Color fundus photograph from a handheld portable camera.
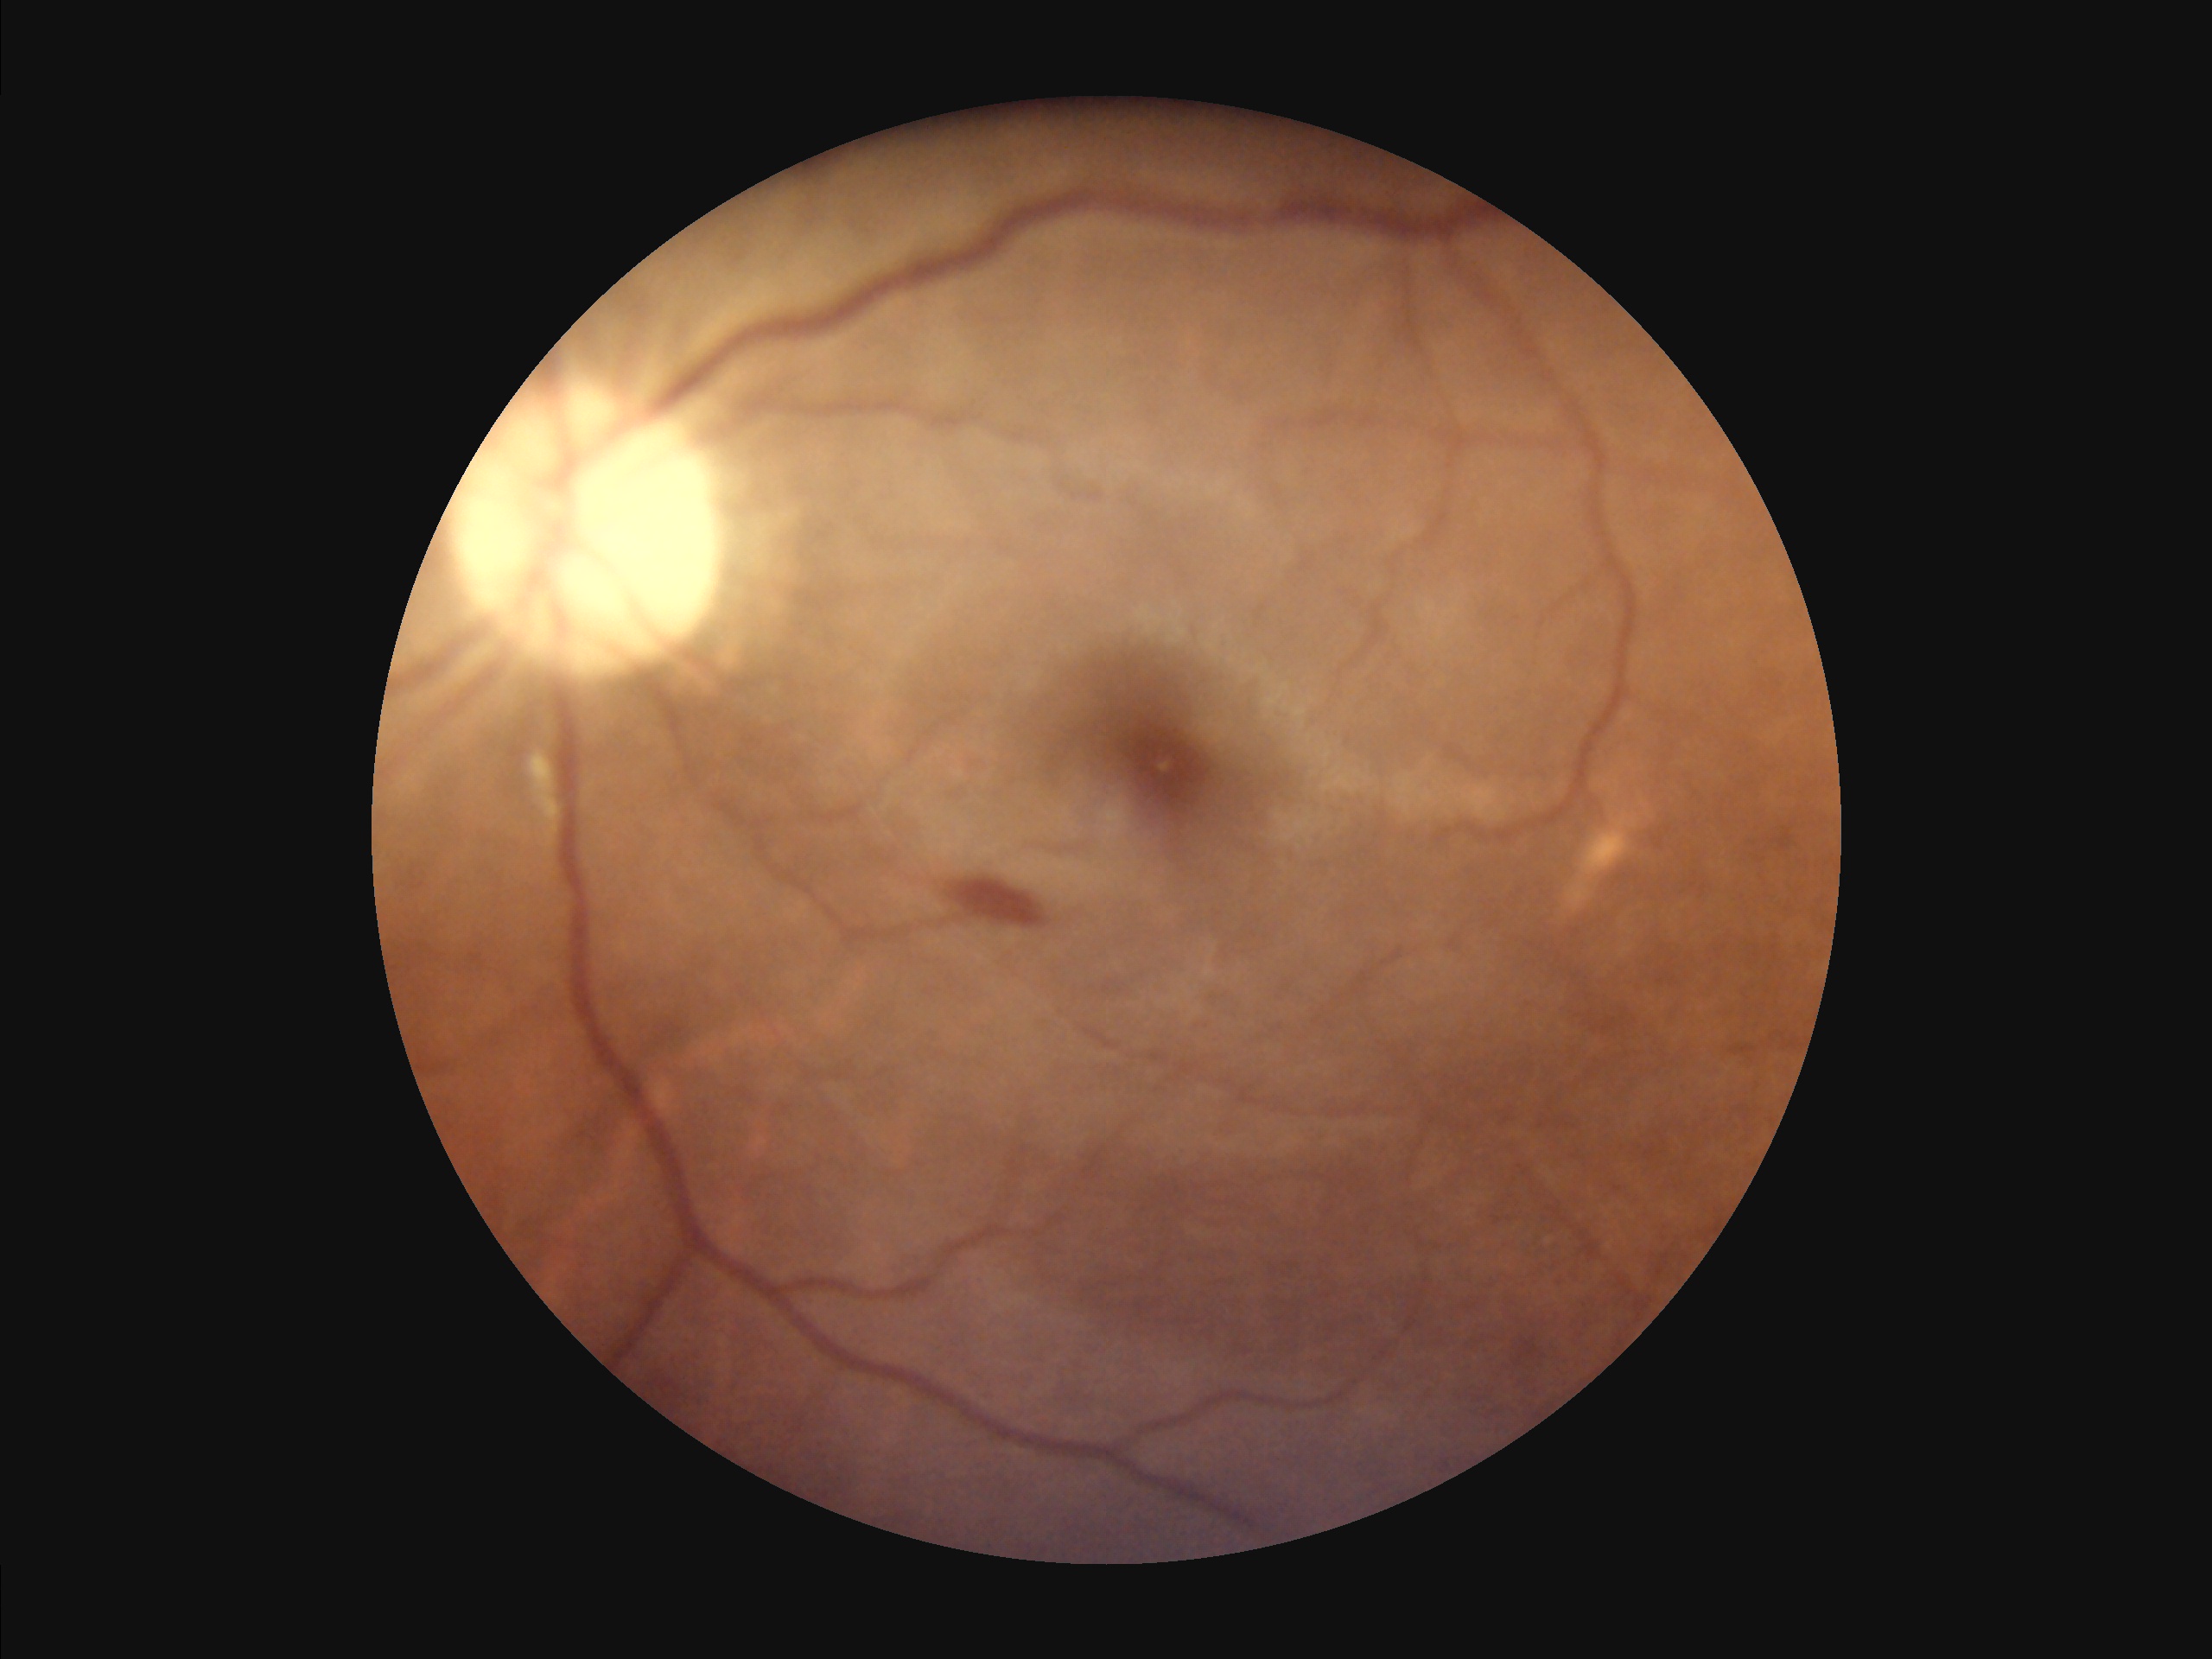 Illumination and color balance are good.
Overall image quality is good.